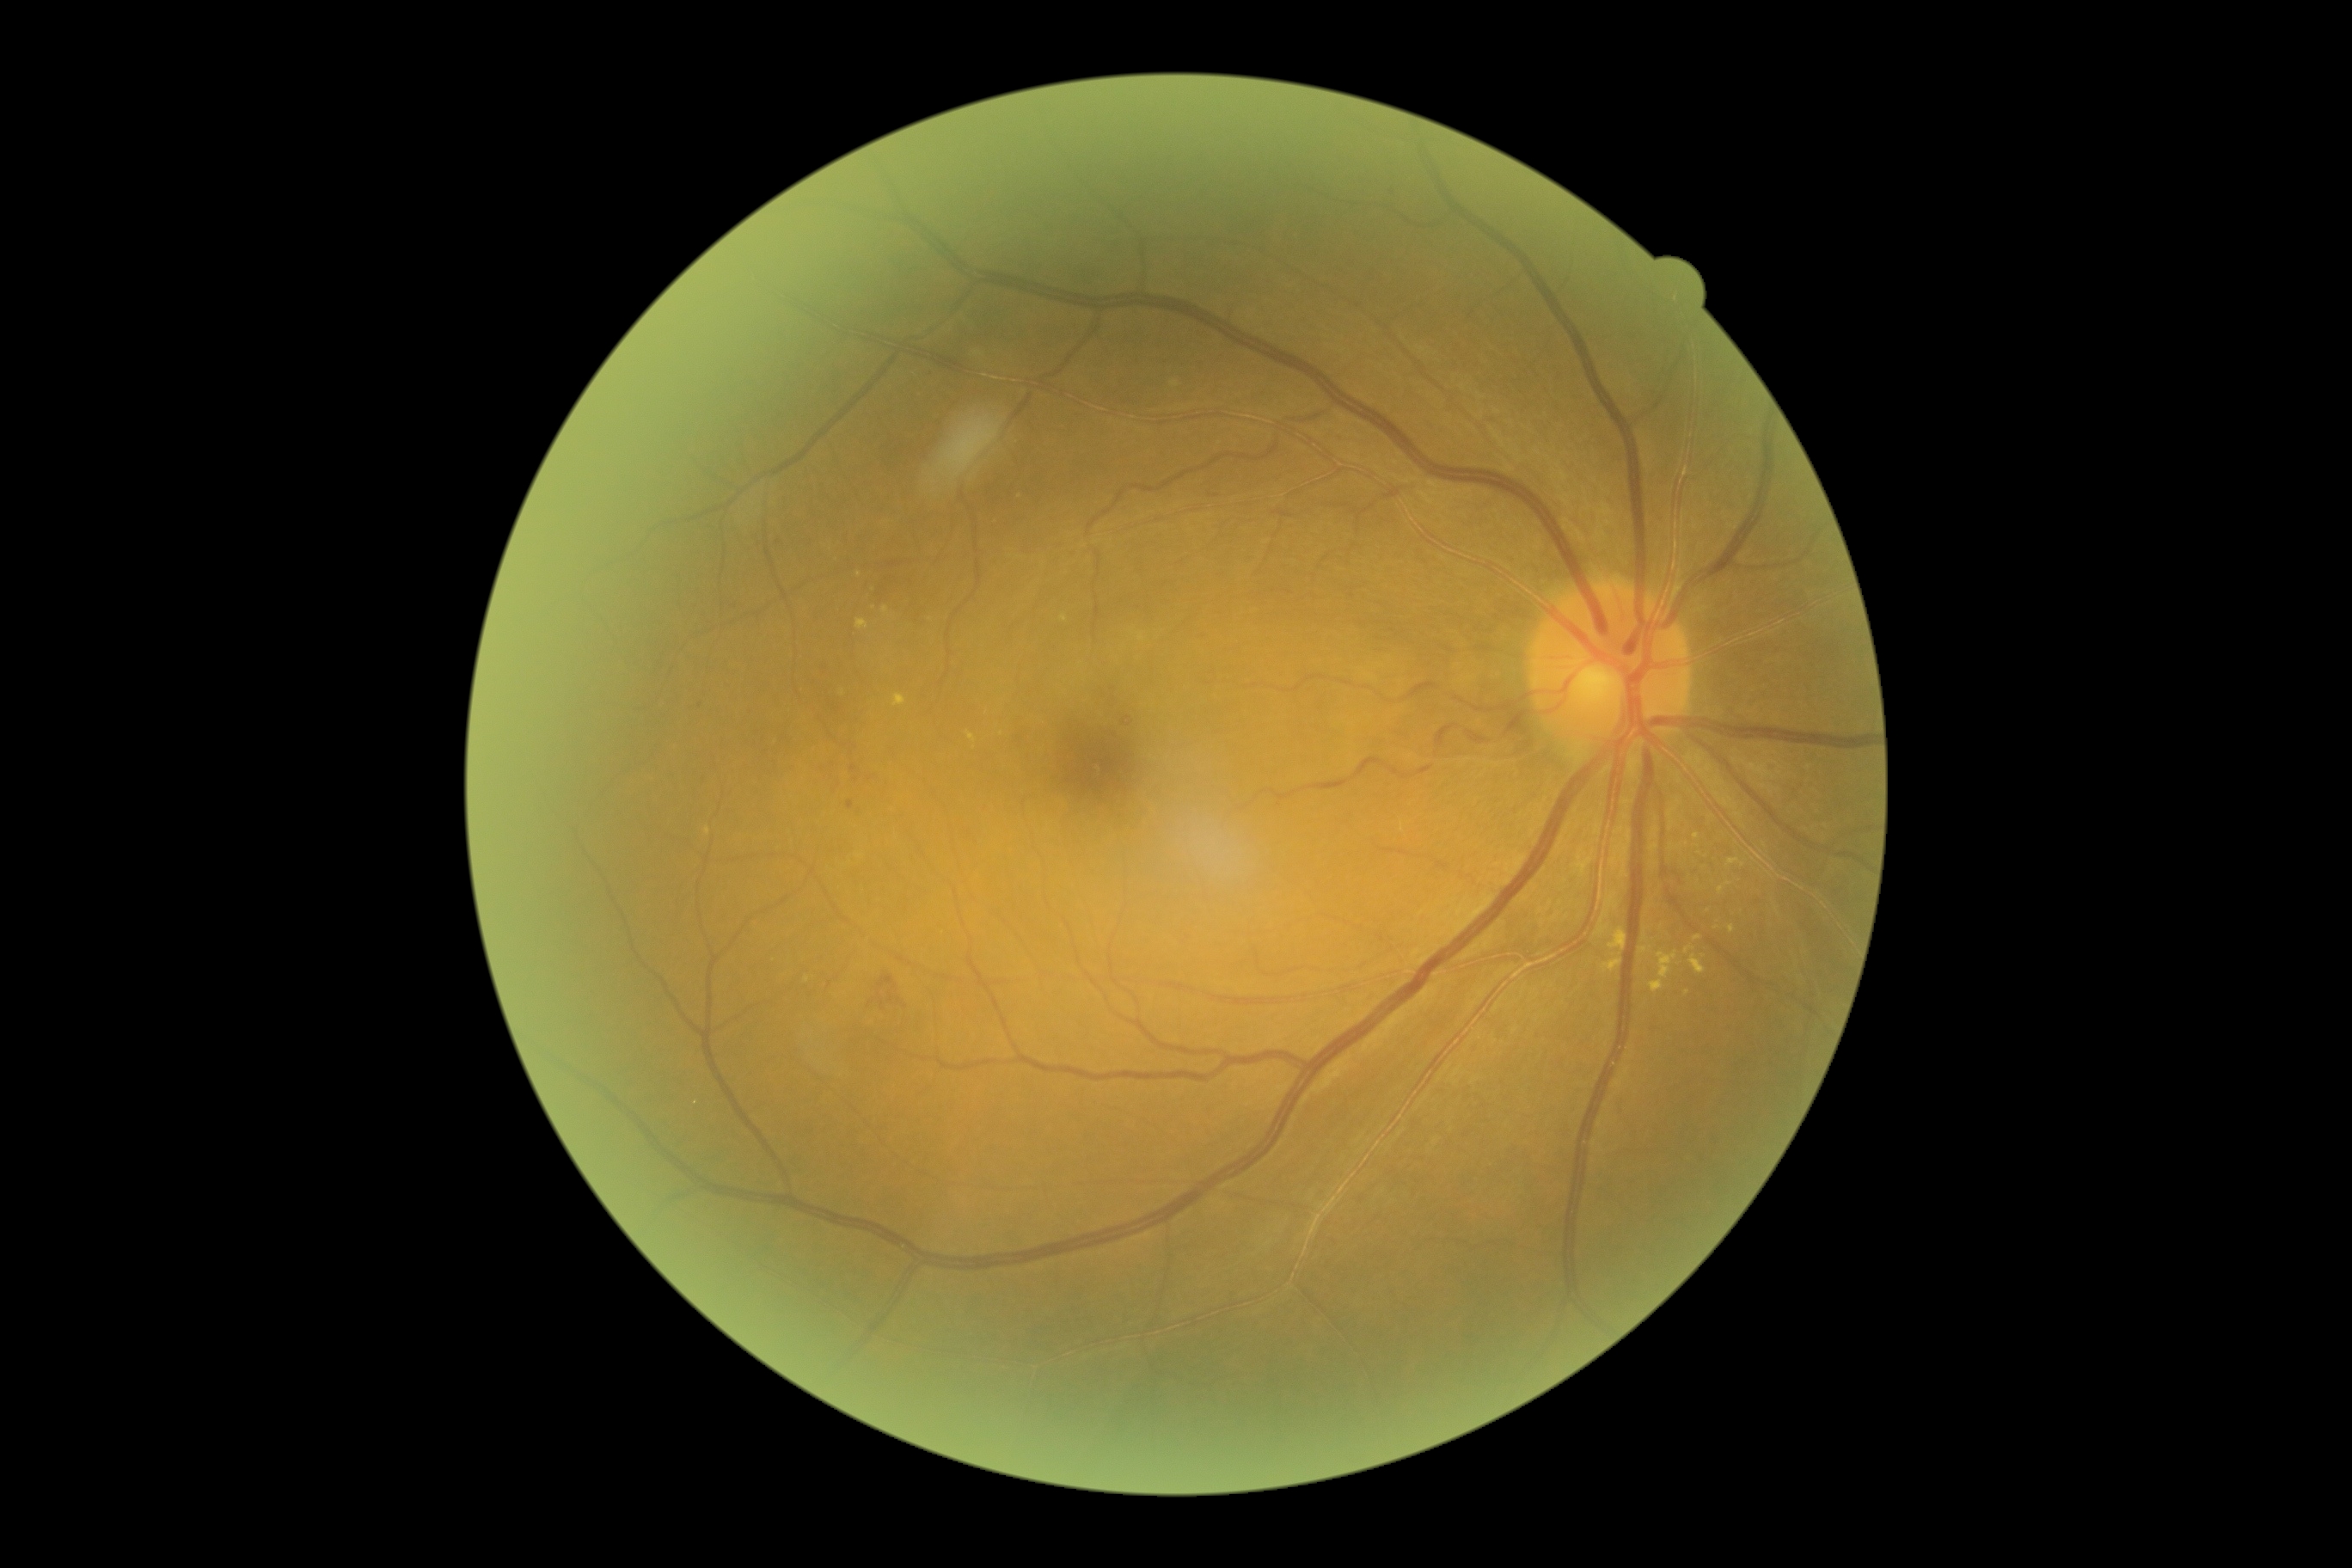

{"partial": true, "dr_grade": 2, "dr_grade_name": "moderate NPDR", "lesions": {"ex": [[1602, 957, 1624, 972], [1729, 924, 1736, 933], [967, 732, 977, 744], [1650, 952, 1679, 993], [1639, 946, 1650, 953], [893, 694, 907, 707], [1684, 945, 1696, 955], [855, 620, 869, 630], [1608, 928, 1627, 955], [1689, 955, 1706, 974]], "ex_small": [[843, 693], [1687, 992], [808, 980], [1716, 927], [1697, 938], [886, 611], [1661, 926], [859, 576], [1644, 938], [1708, 910]], "se": null, "he": [[1122, 718, 1132, 726], [1273, 510, 1292, 518], [1210, 494, 1220, 499], [847, 800, 854, 811], [871, 955, 903, 1015], [821, 747, 852, 797], [1665, 867, 1684, 881]], "he_small": [[857, 779], [853, 768]], "ma": [[1388, 190, 1395, 200]], "ma_small": [[700, 705]]}}